1659 x 2212 pixels — 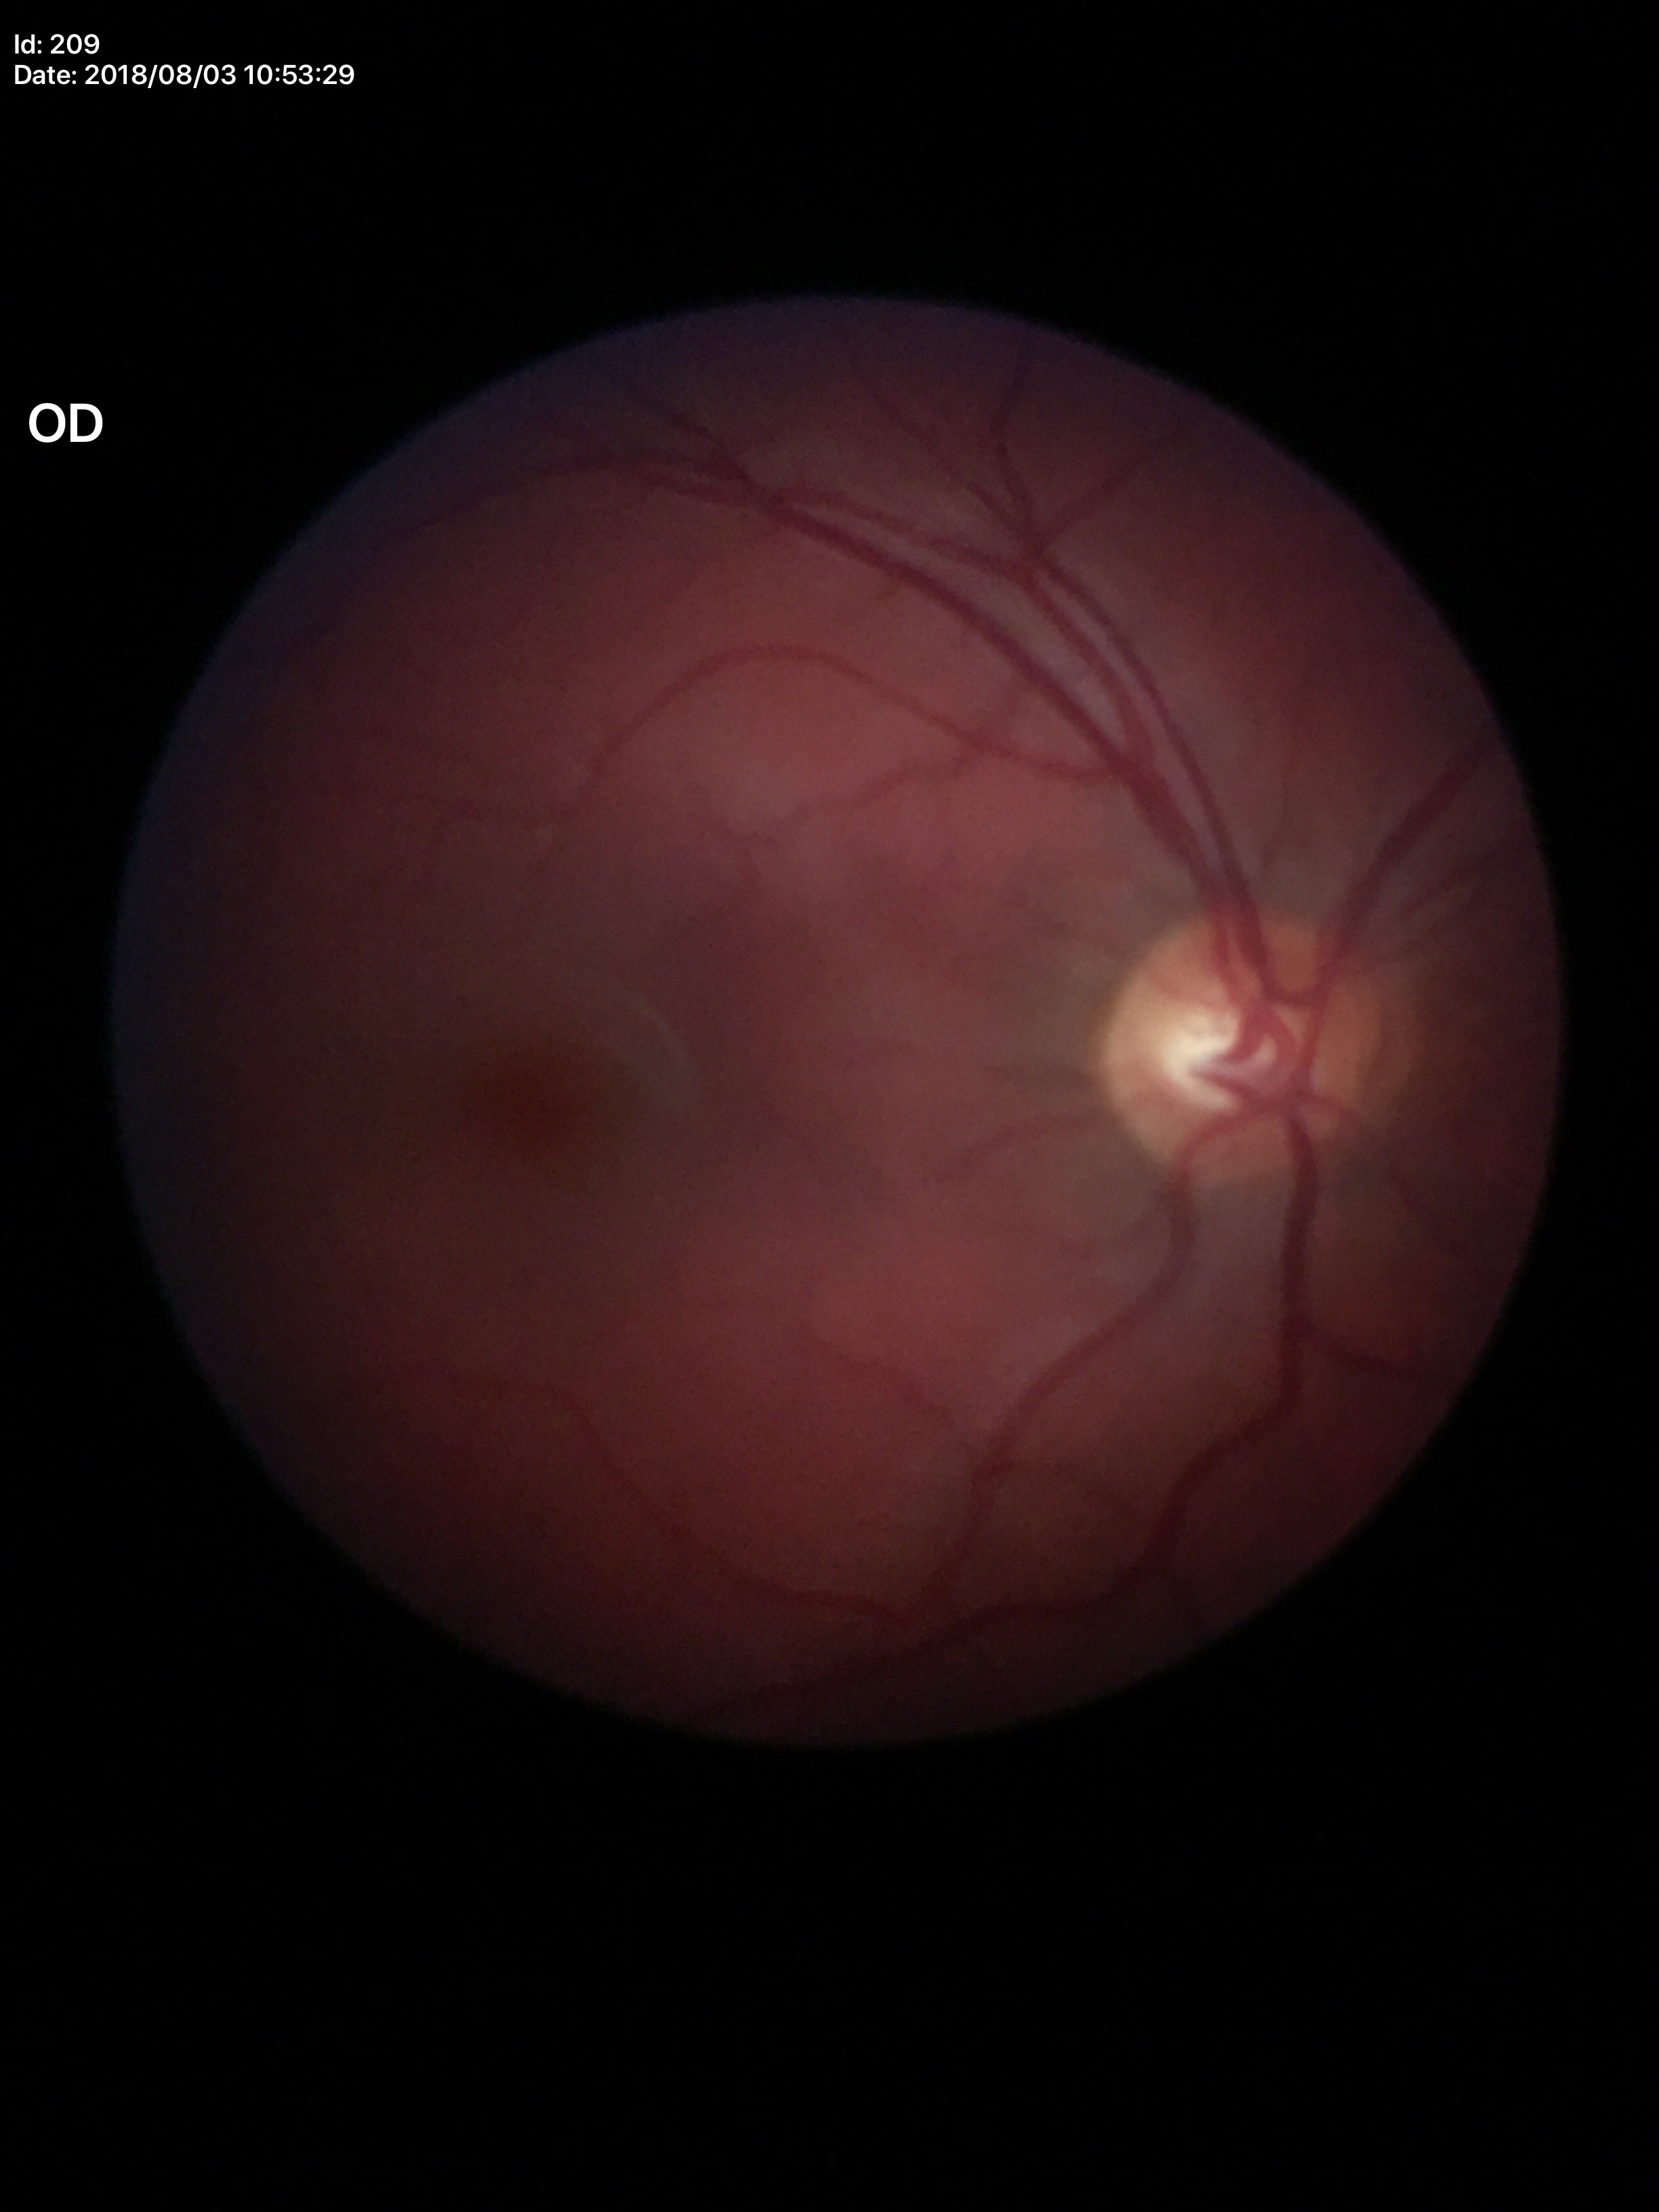

Glaucoma screening impression: not suspect | VCDR: 0.48 | HCDR: 0.53.